Retinal fundus photograph. Topcon TRC-50DX. Dilated-pupil acquisition
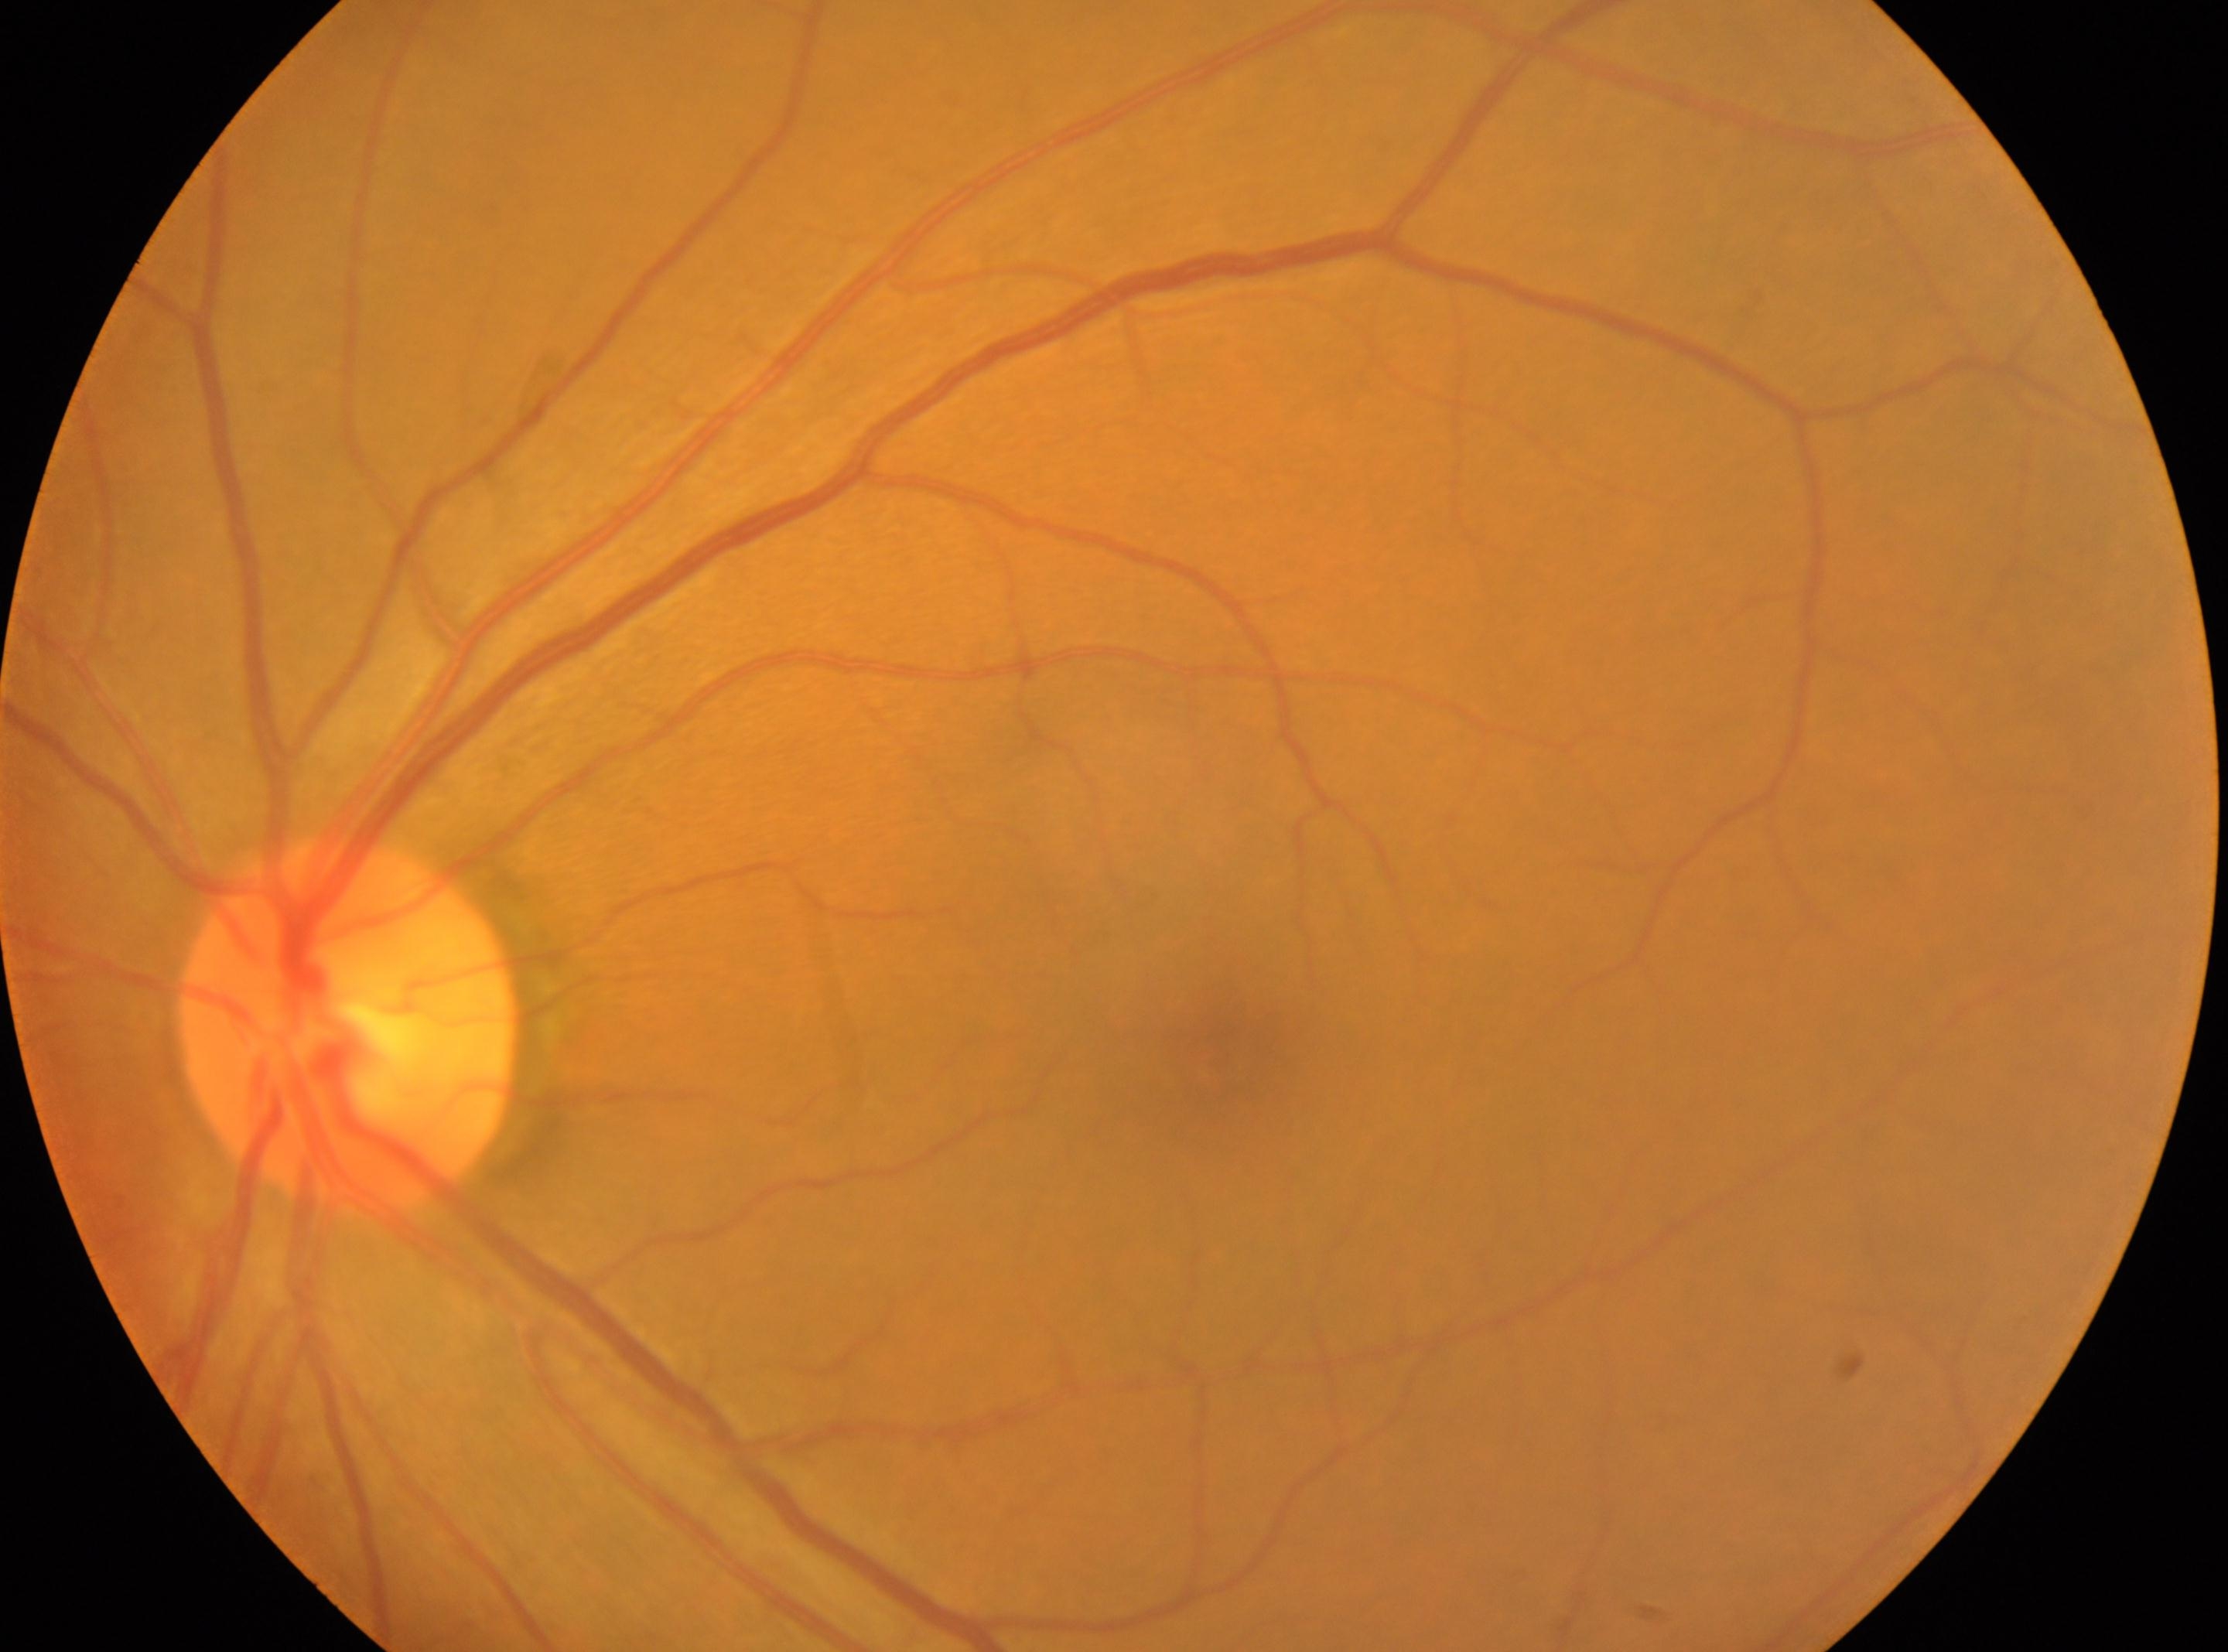
fovea center = (1216,1066) | optic disc center = (351,1026) | laterality = oculus sinister | DR grade = 0.